45° FOV — 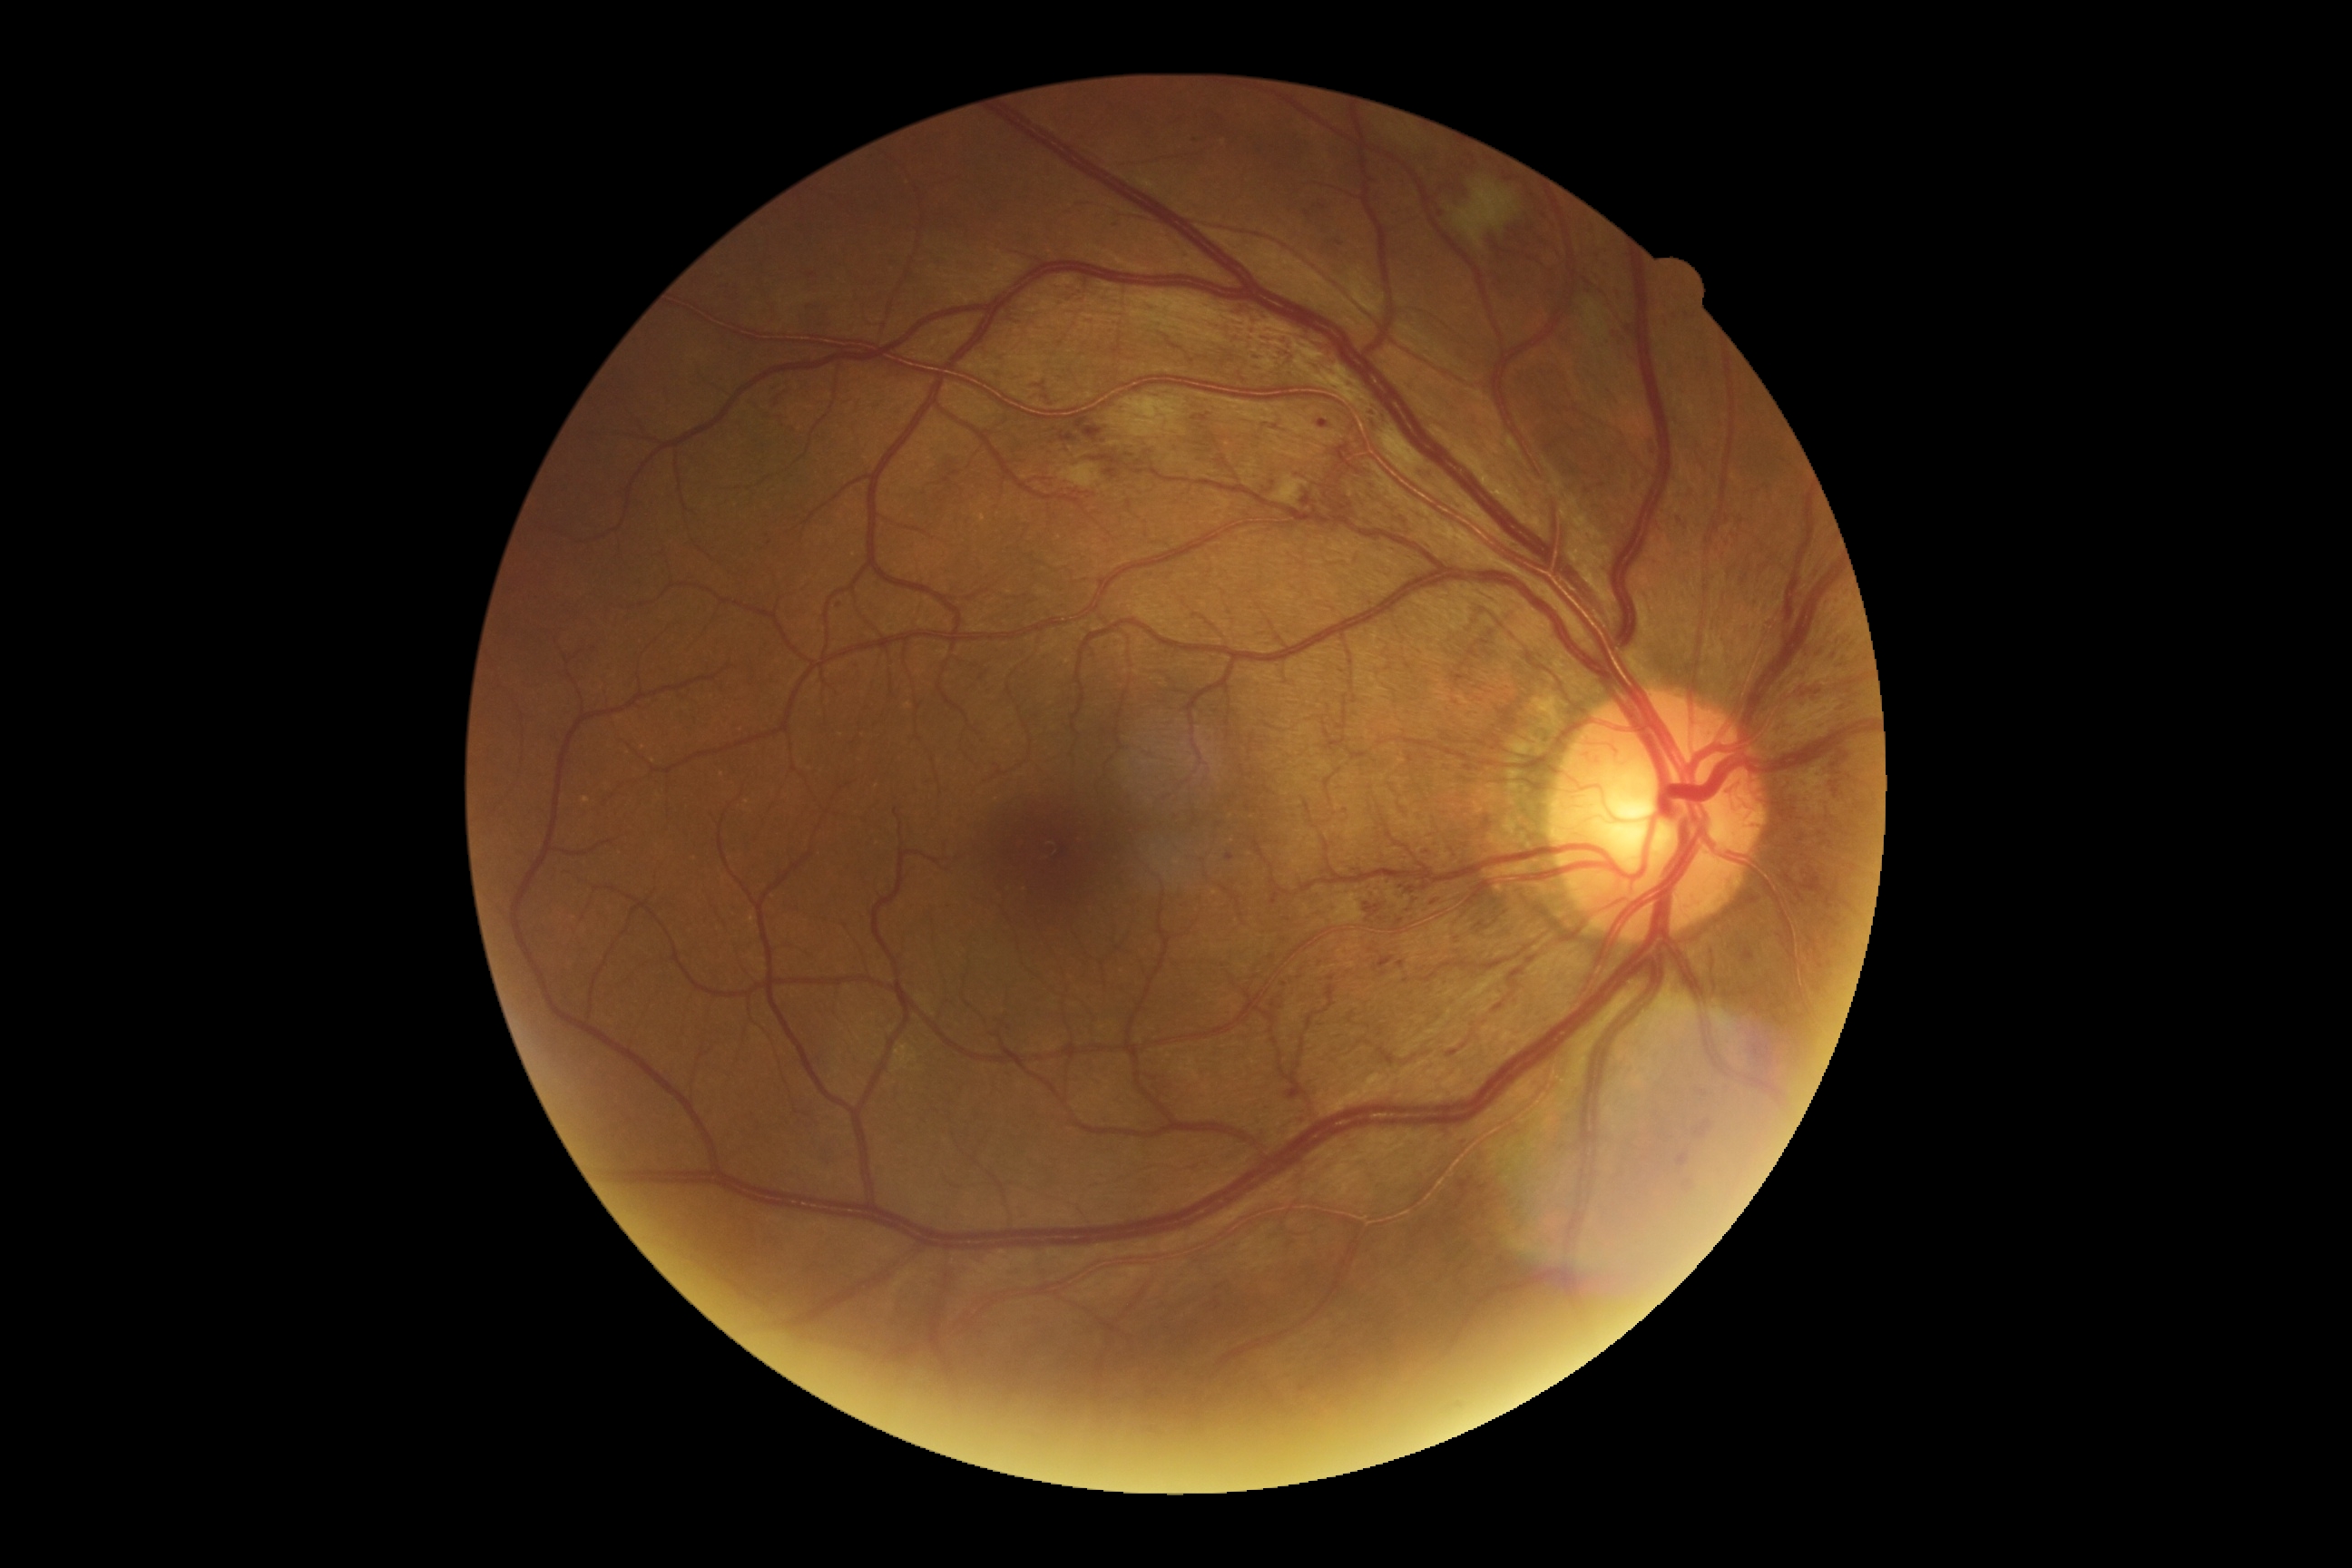 partial: true
dr_grade: 4
dr_grade_name: PDR
lesions:
  ma:
    - [1226, 854, 1235, 863]
    - [1398, 961, 1406, 970]
    - [1318, 420, 1329, 429]
    - [1302, 493, 1315, 507]
    - [1298, 1117, 1306, 1126]
    - [1411, 899, 1422, 905]
  ma_small_centers:
    - x=1115 y=223
    - x=1588 y=492
    - x=1602 y=485
    - x=839 y=606
    - x=1383 y=974
    - x=1679 y=522
    - x=769 y=544
    - x=1205 y=419
    - x=1407 y=982
  ex: []
  he:
    - [1375, 957, 1395, 972]
    - [1037, 393, 1050, 404]
    - [1364, 903, 1382, 921]
    - [1284, 1084, 1300, 1101]
    - [1404, 881, 1429, 896]
    - [1035, 384, 1046, 389]
    - [776, 387, 789, 409]
    - [808, 273, 816, 279]
    - [1059, 433, 1077, 442]
    - [1072, 415, 1102, 442]
    - [1104, 469, 1119, 480]
    - [1326, 487, 1353, 516]
  he_small_centers:
    - x=1401 y=922
  se:
    - [1273, 476, 1309, 507]
    - [1378, 426, 1435, 495]
    - [1106, 398, 1188, 438]
    - [1061, 464, 1101, 489]
    - [1455, 182, 1518, 248]